Fundus photo: 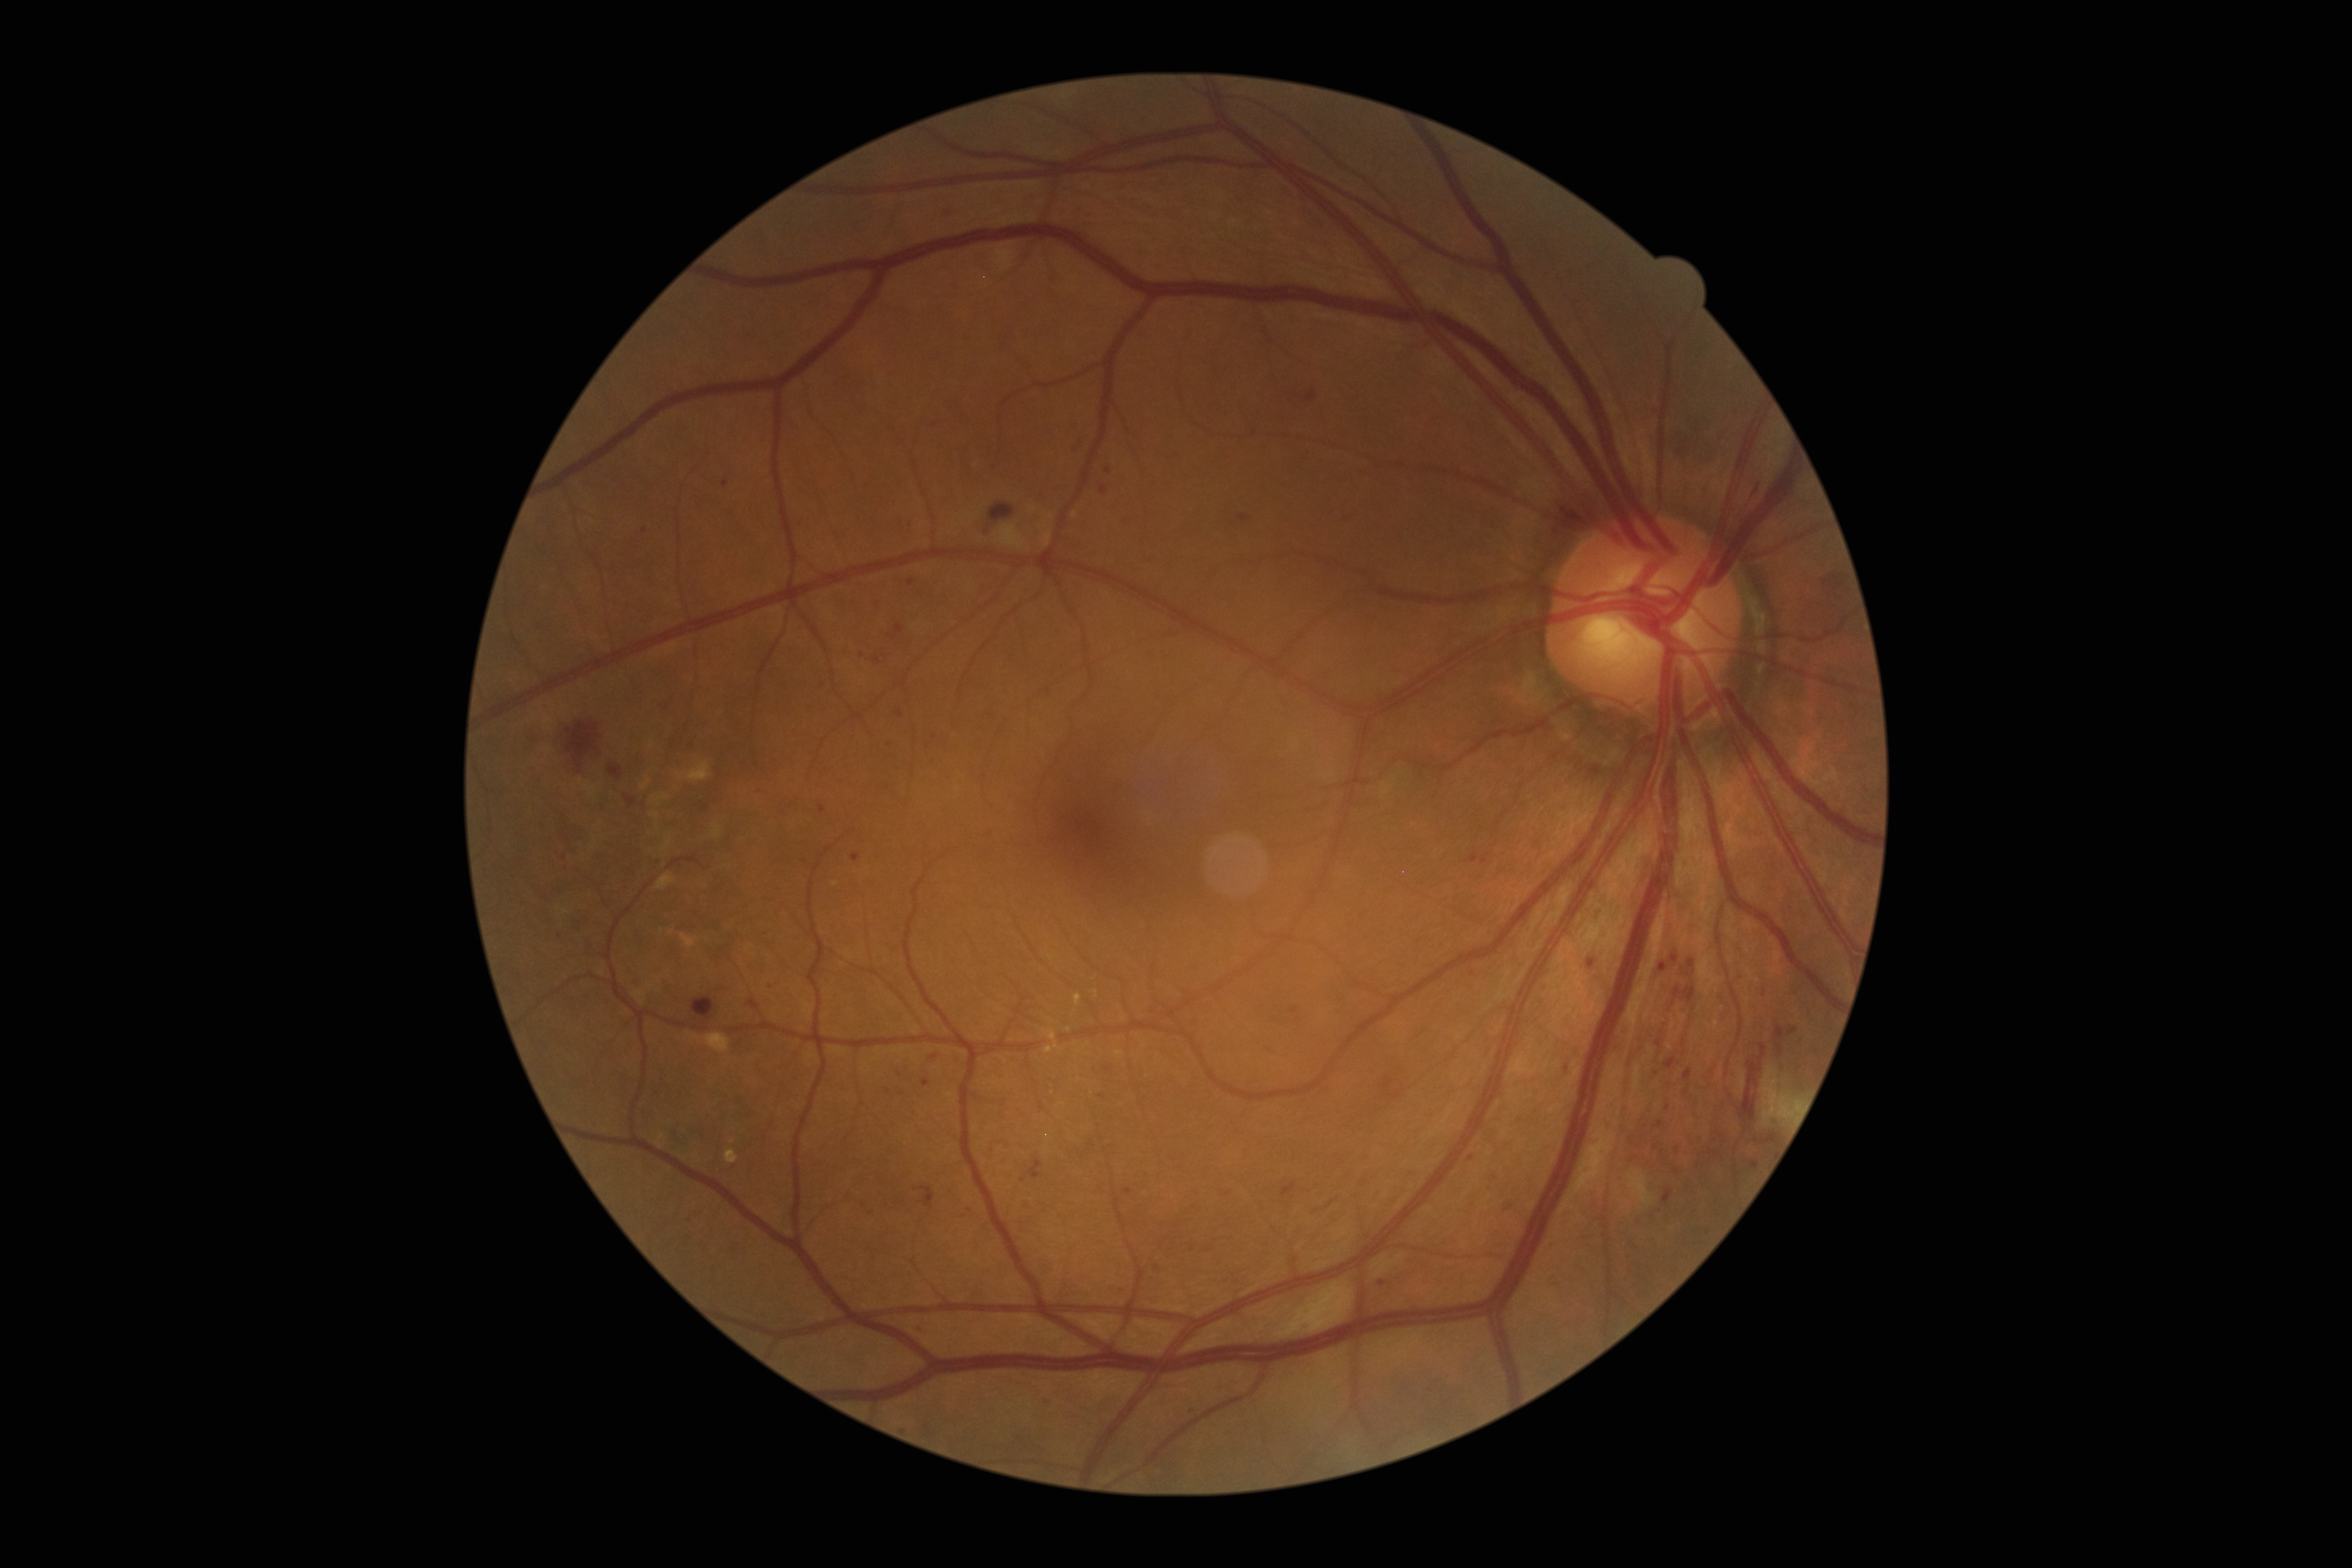
Diabetic retinopathy (DR): moderate non-proliferative diabetic retinopathy (grade 2)
Selected lesions:
hemorrhages (HEs): 693:998:714:1019 | 1671:955:1679:962 | 1740:1044:1768:1121 | 1565:501:1586:526 | 1659:962:1667:971 | 1688:959:1696:969 | 989:503:1014:521 | 1305:394:1317:402 | 566:722:601:769 | 1673:987:1696:1002 | 624:794:637:808 | 609:765:622:780
Small HEs approximately at Point(1673, 1003)
microaneurysms (MAs) (continued): 1502:1200:1513:1212 | 1469:854:1478:862 | 916:1323:925:1334 | 820:805:826:814 | 1563:1064:1569:1075 | 1777:1044:1783:1053 | 874:656:880:664 | 1344:518:1356:528 | 1282:1183:1295:1195 | 914:1186:935:1208
Small MAs approximately at Point(1102, 1096) | Point(1662, 1151) | Point(861, 655) | Point(860, 1203) | Point(900, 714) | Point(1591, 963) | Point(935, 1056) | Point(645, 530) | Point(1668, 1107)
soft exudates (SEs): 1629:1172:1655:1206 | 1763:1080:1803:1121 | 1571:1127:1617:1195 | 705:1034:730:1053 | 1273:1282:1354:1339 | 1765:1065:1777:1082 | 1375:1254:1404:1277 | 995:244:1014:273
hard exudates (EXs) (continued): 679:933:696:947 | 654:795:659:803 | 712:823:722:839 | 658:873:677:890 | 661:839:672:851 | 1045:1044:1059:1053 | 725:1149:739:1163 | 1115:1051:1125:1057 | 1074:993:1081:1006 | 1042:1029:1056:1041 | 677:760:712:782 | 655:812:660:820
Small EXs approximately at Point(670, 933) | Point(644, 787) | Point(666, 797) | Point(732, 1141) | Point(1069, 1030) | Point(648, 782)